Handheld portable fundus camera image
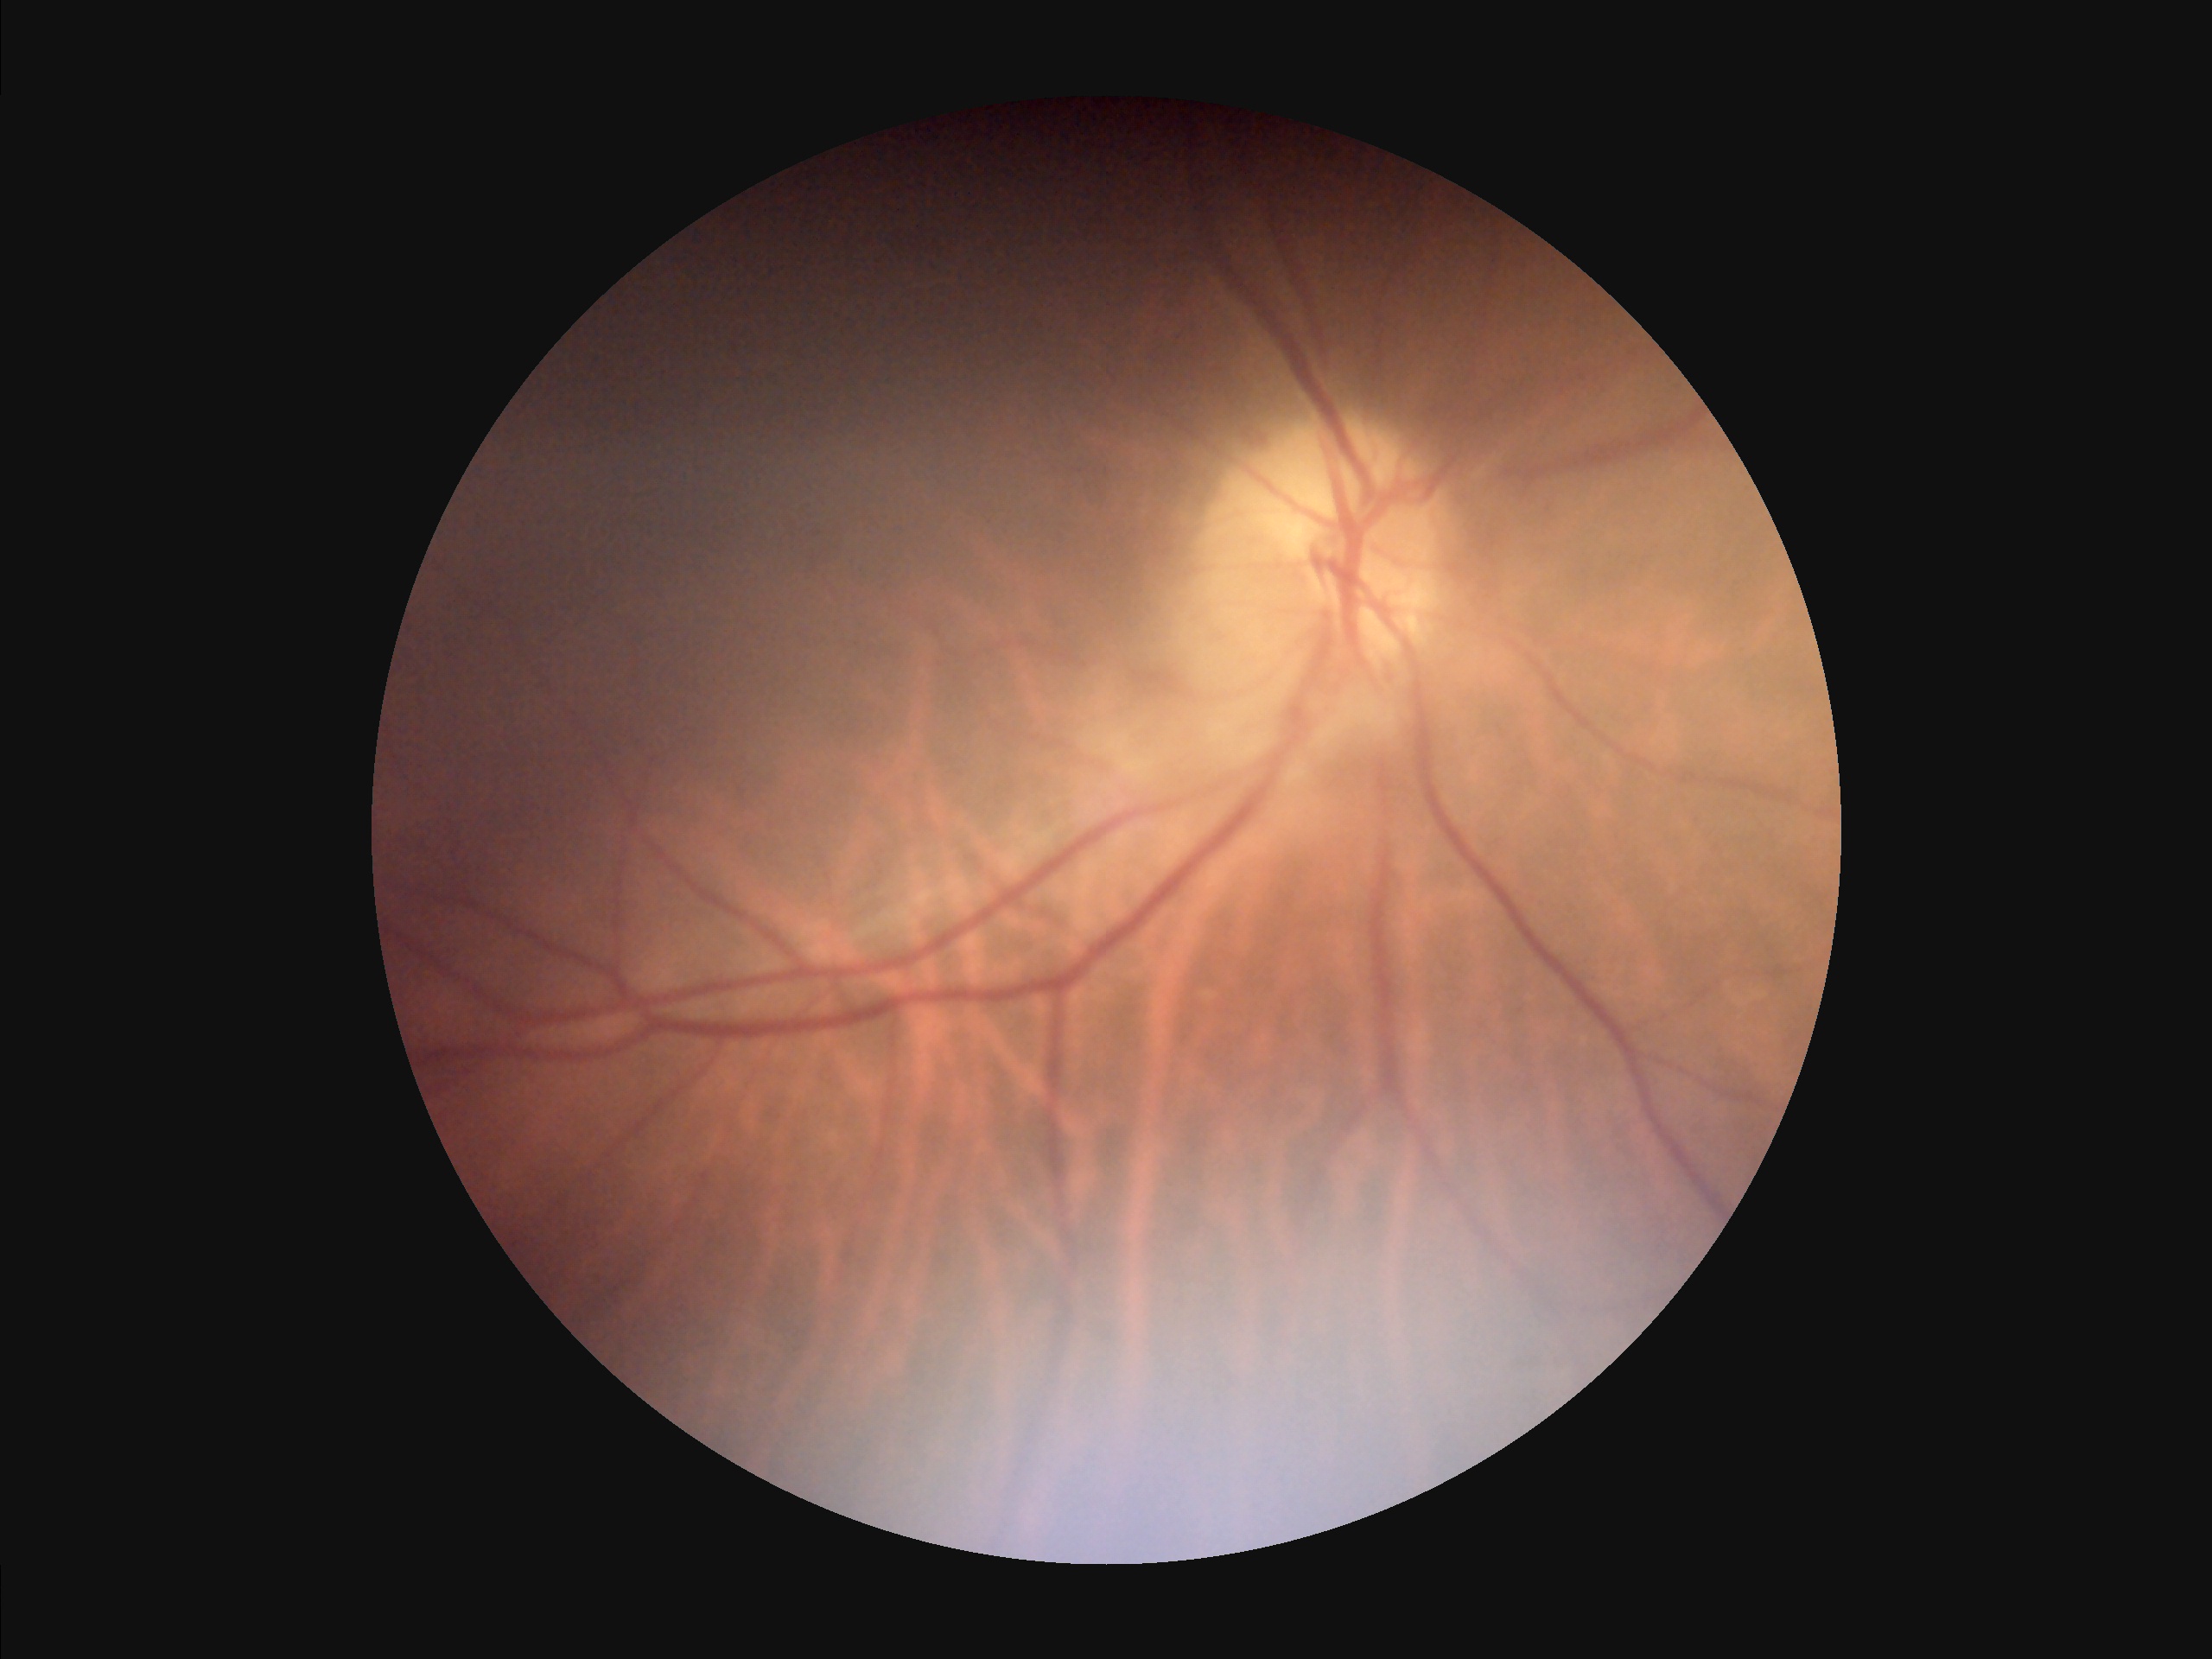

Contrast is good. Illumination and color are suboptimal. Overall image quality is poor.